848 by 848 pixels, 45-degree field of view, no pharmacologic dilation, NIDEK AFC-230 fundus camera — 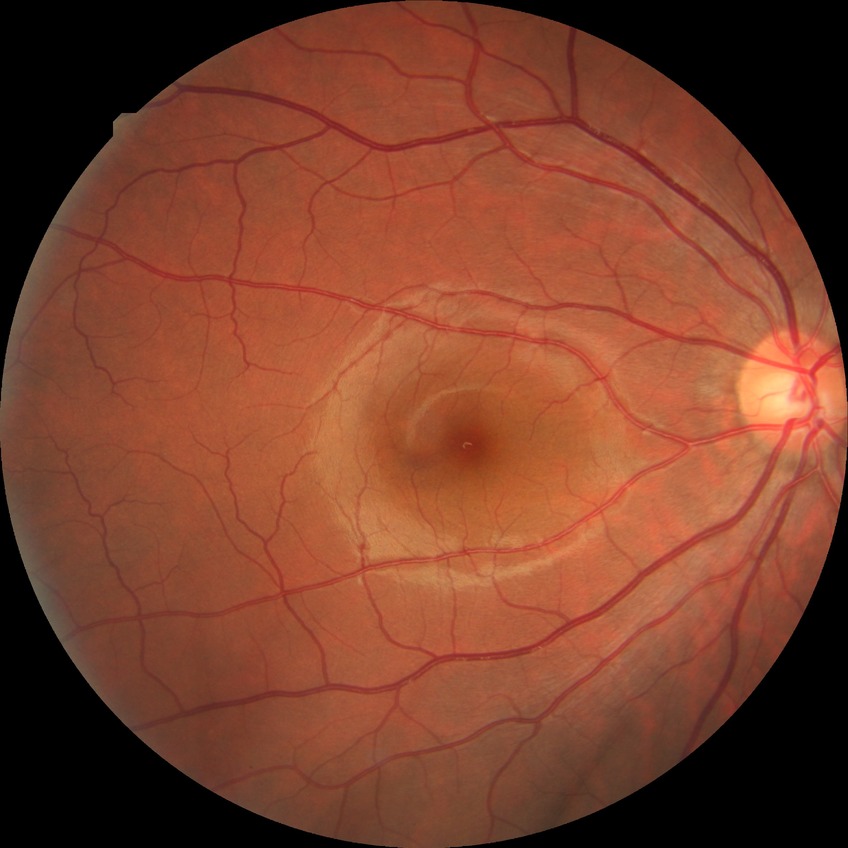 retinopathy grade@no diabetic retinopathy.